Camera: NIDEK AFC-230
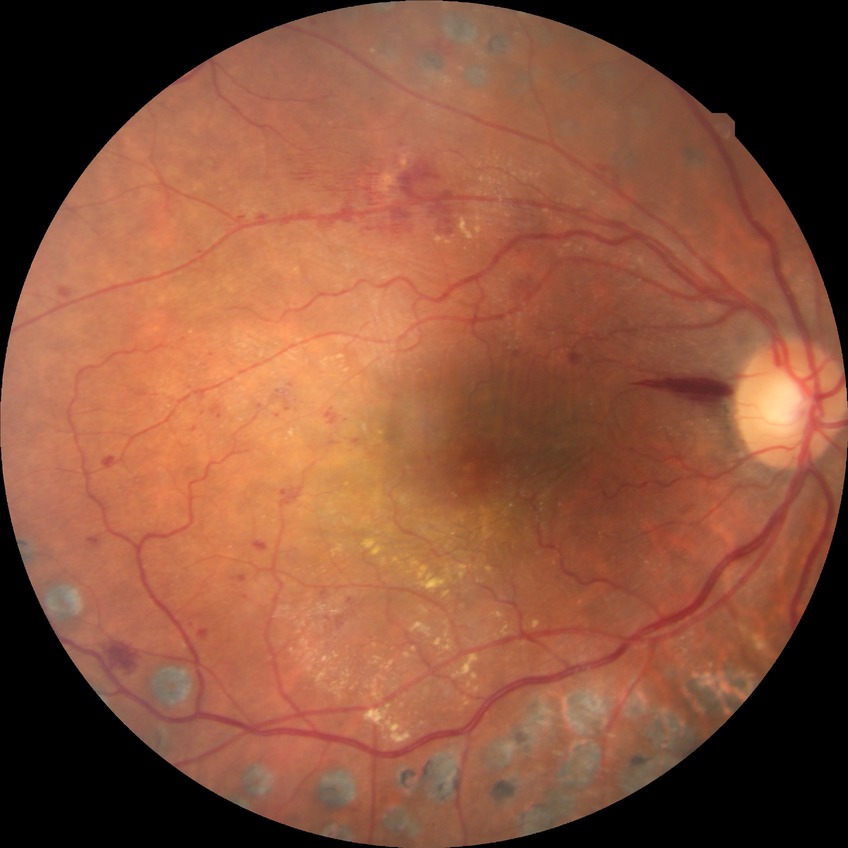

Diabetic retinopathy (DR): PDR (proliferative diabetic retinopathy).